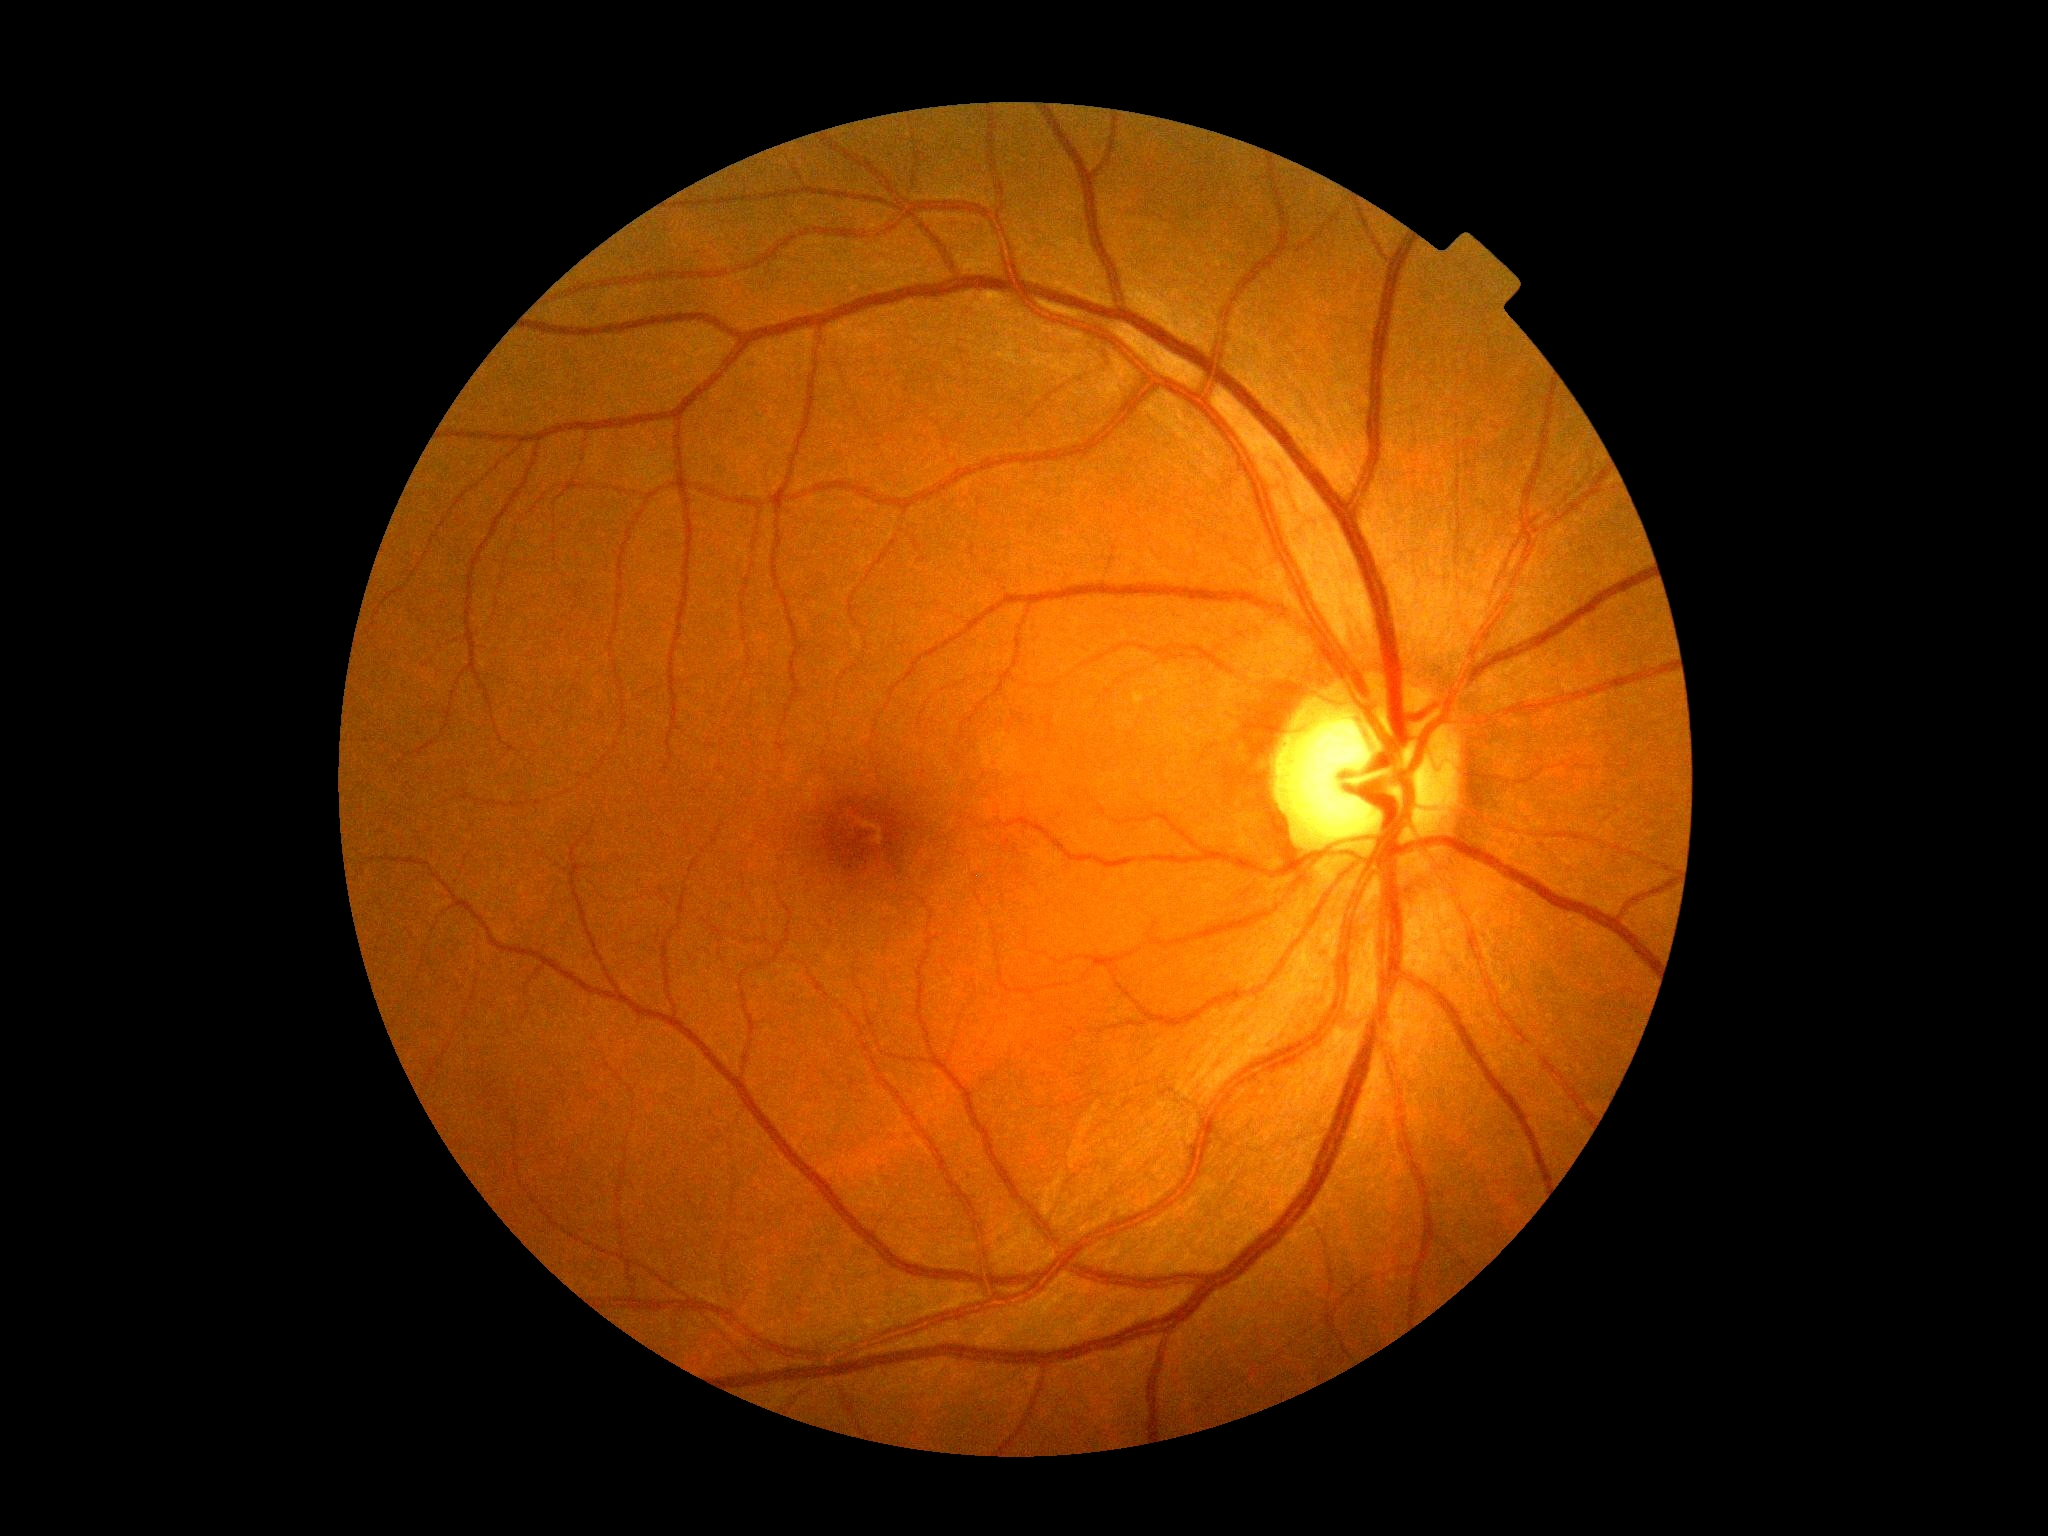

DR severity is grade 0 (no apparent retinopathy). No signs of diabetic retinopathy.